Camera: NIDEK AFC-230 · 45 degree fundus photograph · color fundus image:
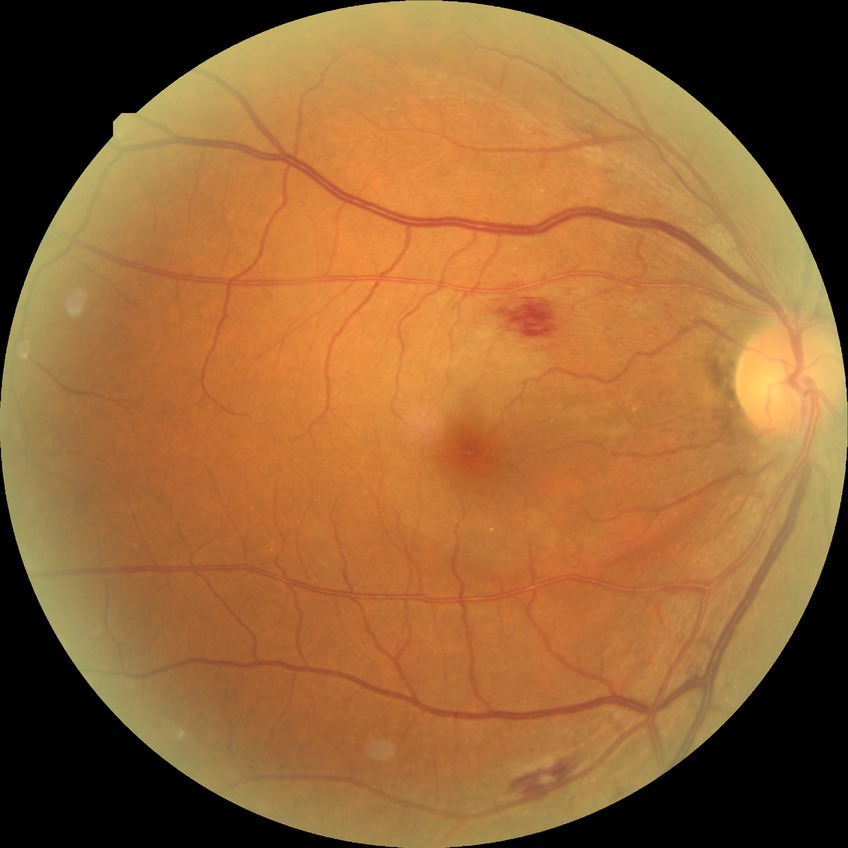
Diabetic retinopathy stage: simple diabetic retinopathy. DR class: non-proliferative diabetic retinopathy.